Color fundus photograph. Nonmydriatic fundus photograph.
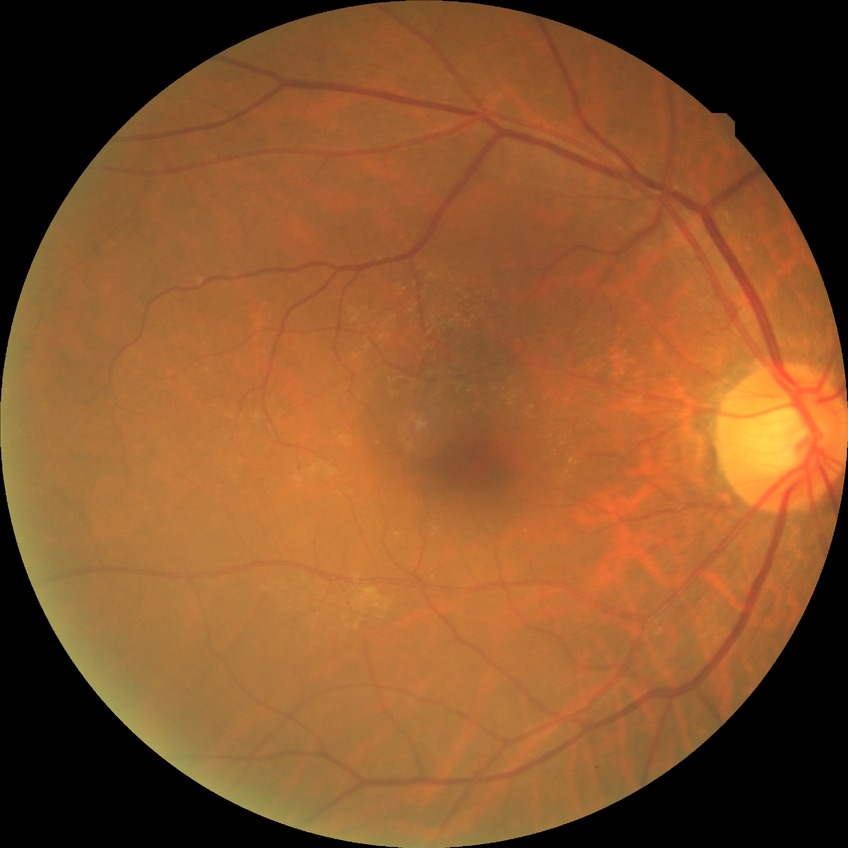 Diabetic retinopathy (DR) is NDR (no diabetic retinopathy).